Posterior pole color fundus photograph; 45° FOV.
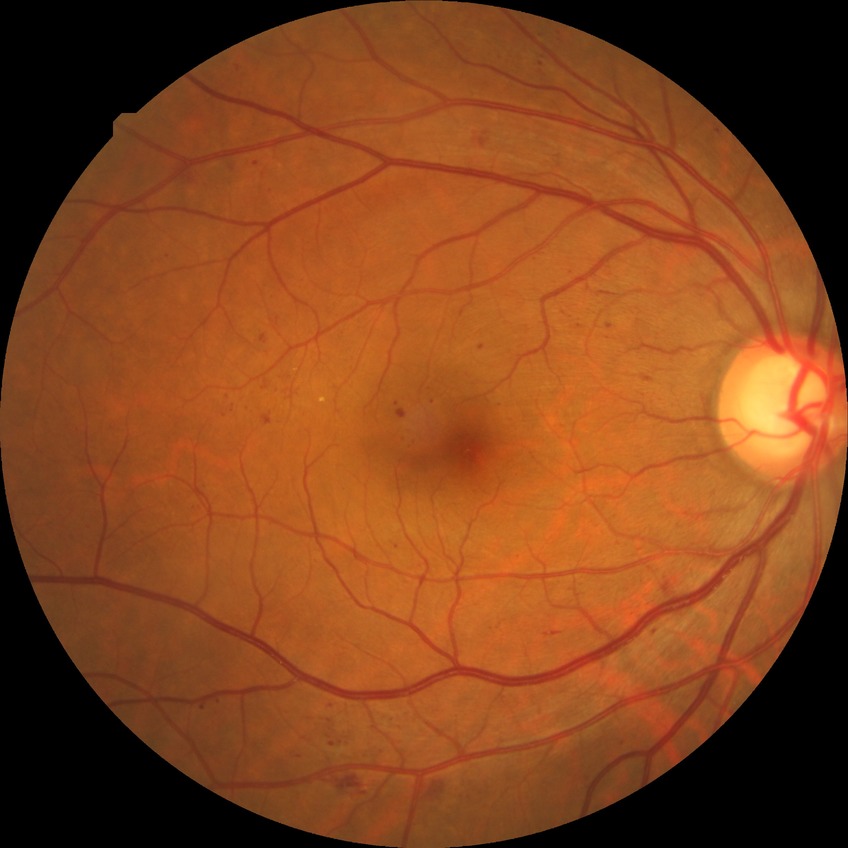

Diabetic retinopathy (DR): SDR (simple diabetic retinopathy). The retinopathy is classified as non-proliferative diabetic retinopathy.